Modified Davis grading. 848x848. Without pupil dilation.
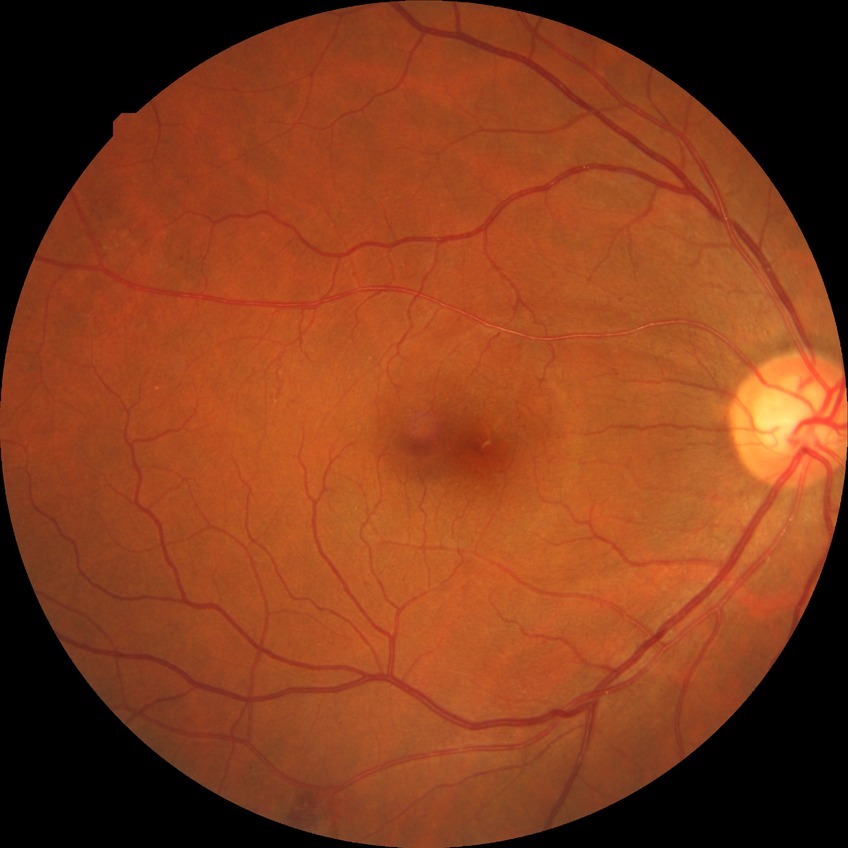
diabetic retinopathy (DR)=pre-proliferative diabetic retinopathy (PPDR).